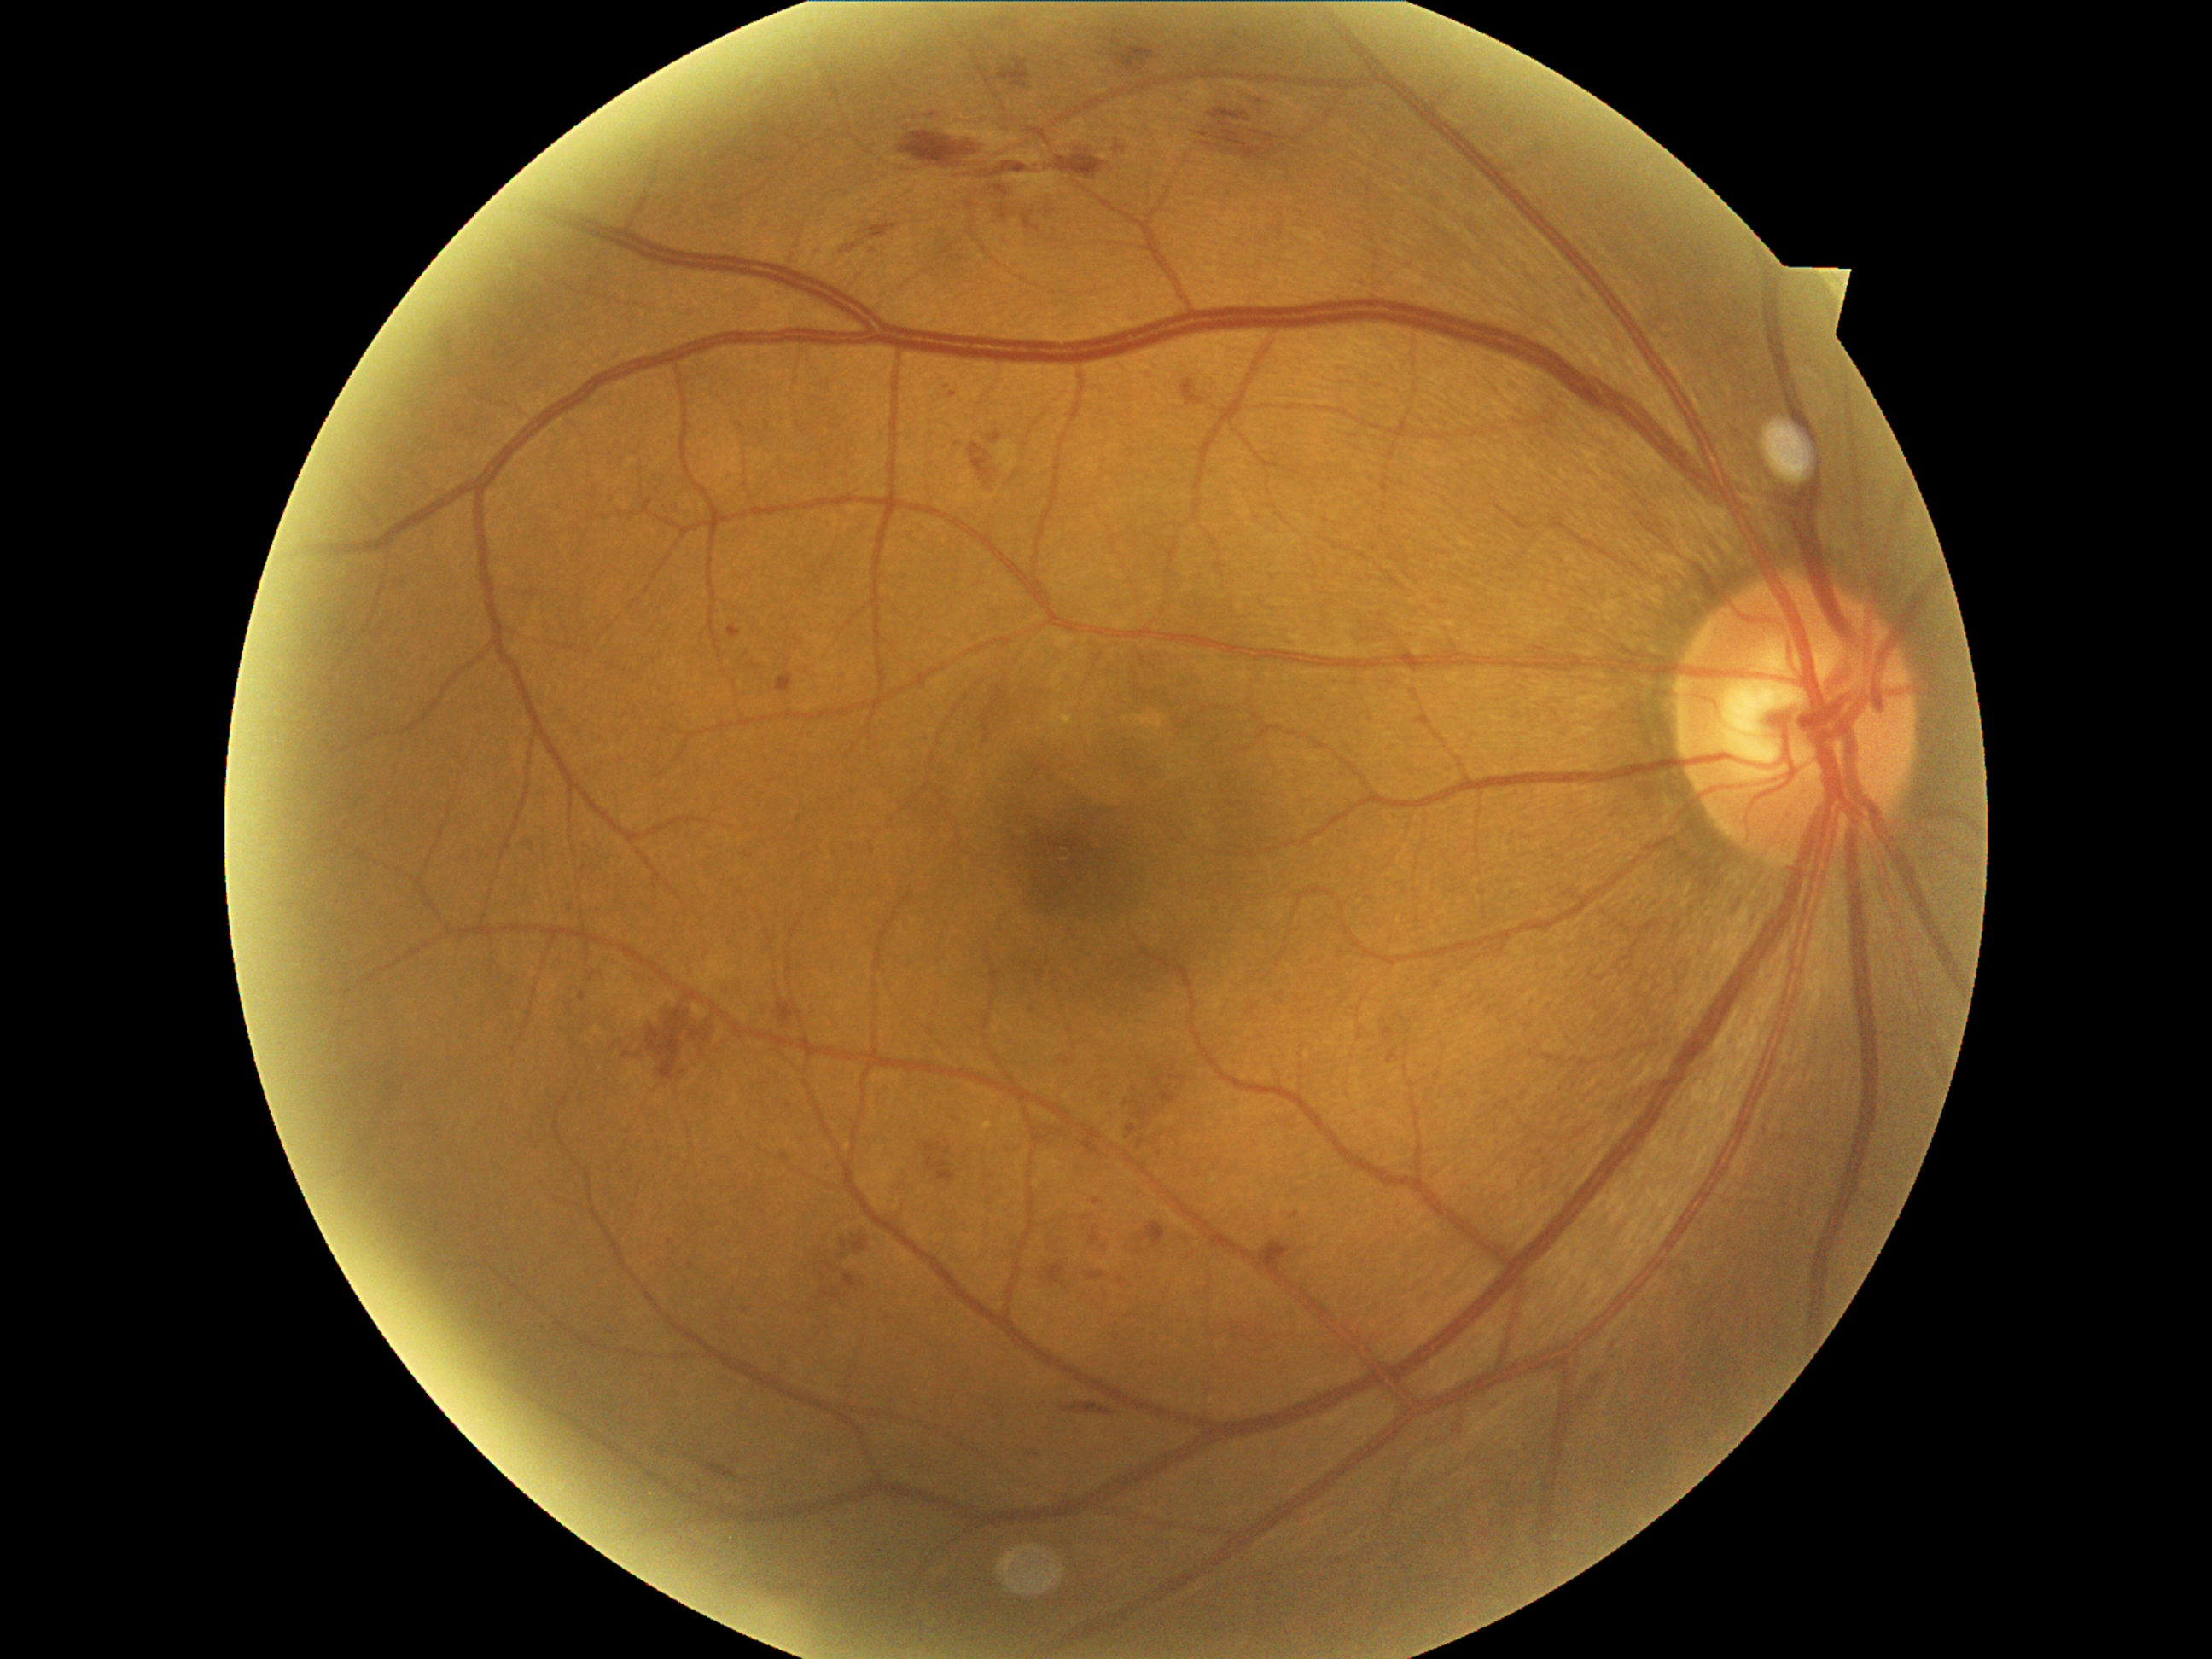

{"partial": true, "dr_grade": 2, "lesions": {"se": null, "ma": [[728, 626, 742, 639], [643, 499, 655, 508], [579, 992, 586, 1003], [569, 904, 574, 912], [525, 842, 537, 853]], "ma_small_approx": [[627, 1054], [691, 1266], [873, 252], [1065, 1062], [955, 1119], [790, 1106], [745, 1310], [955, 395], [1297, 1216]], "ex": null, "he": [[871, 224, 895, 238], [899, 132, 981, 170], [970, 445, 999, 489], [837, 1231, 870, 1262], [1132, 1100, 1141, 1107], [1127, 1105, 1158, 1136], [996, 185, 1010, 197], [1146, 1223, 1167, 1249], [1093, 1197, 1102, 1206], [1086, 1271, 1105, 1281], [841, 236, 868, 253], [1037, 969, 1045, 984], [1160, 1088, 1177, 1105], [1090, 1230, 1098, 1247], [648, 1003, 714, 1081]], "he_small_approx": [[1110, 1132], [1128, 1104], [1030, 1455], [1084, 1218]]}}